512x512px: 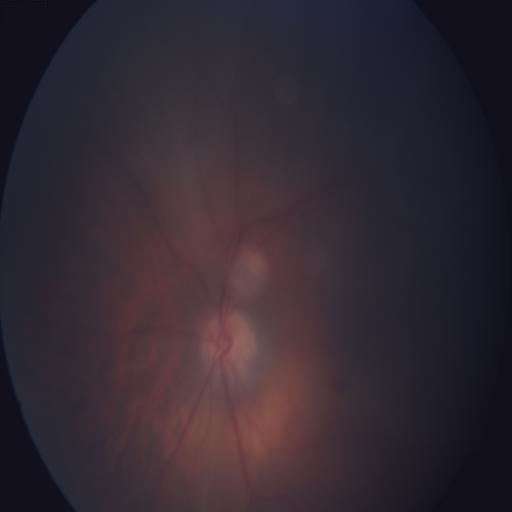 Findings consistent with chorioretinitis.